Graded on the modified Davis scale. 848x848:
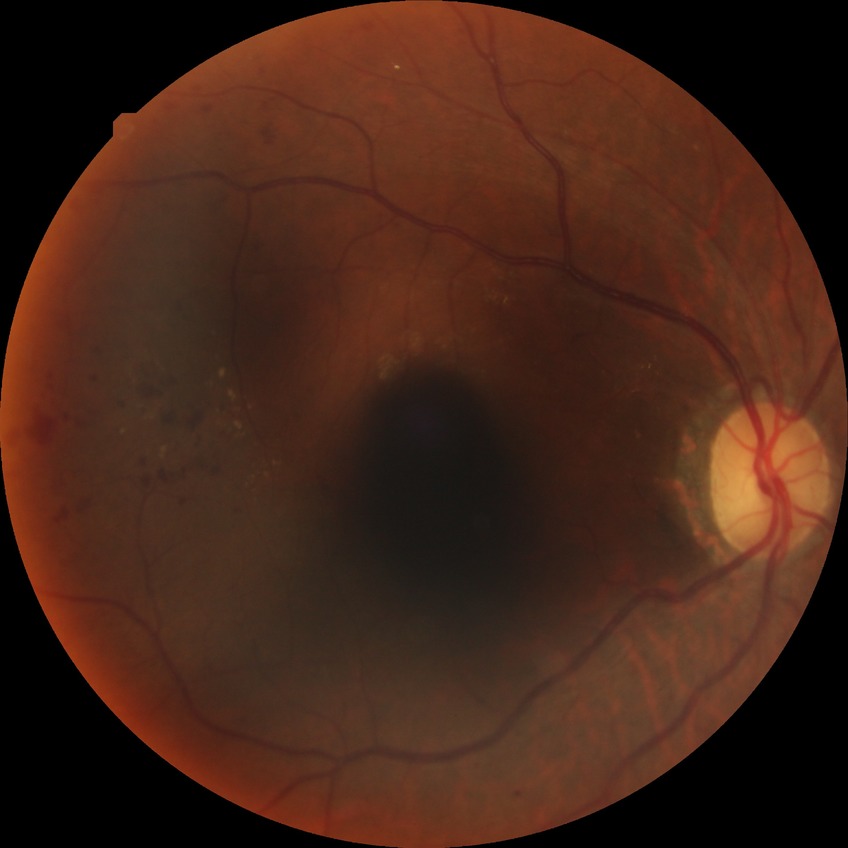
Diabetic retinopathy (DR) is SDR (simple diabetic retinopathy).